Infant wide-field fundus photograph. 1240x1240
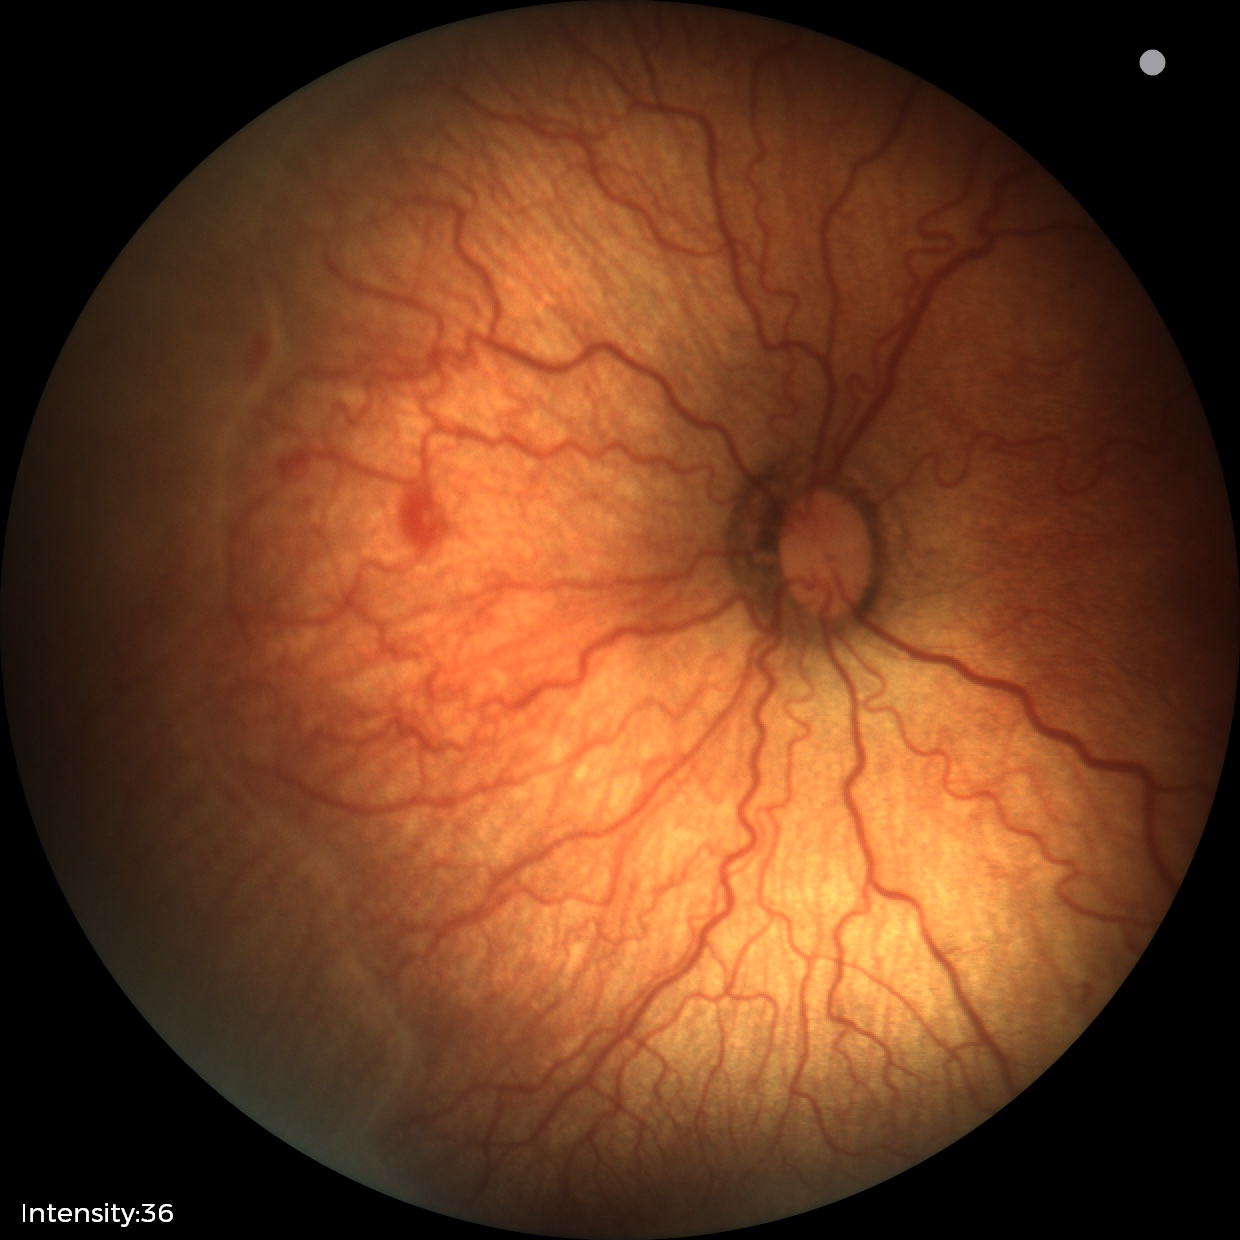
Finding = retinopathy of prematurity (ROP) stage 2; plus form = present.